Infant wide-field retinal image: 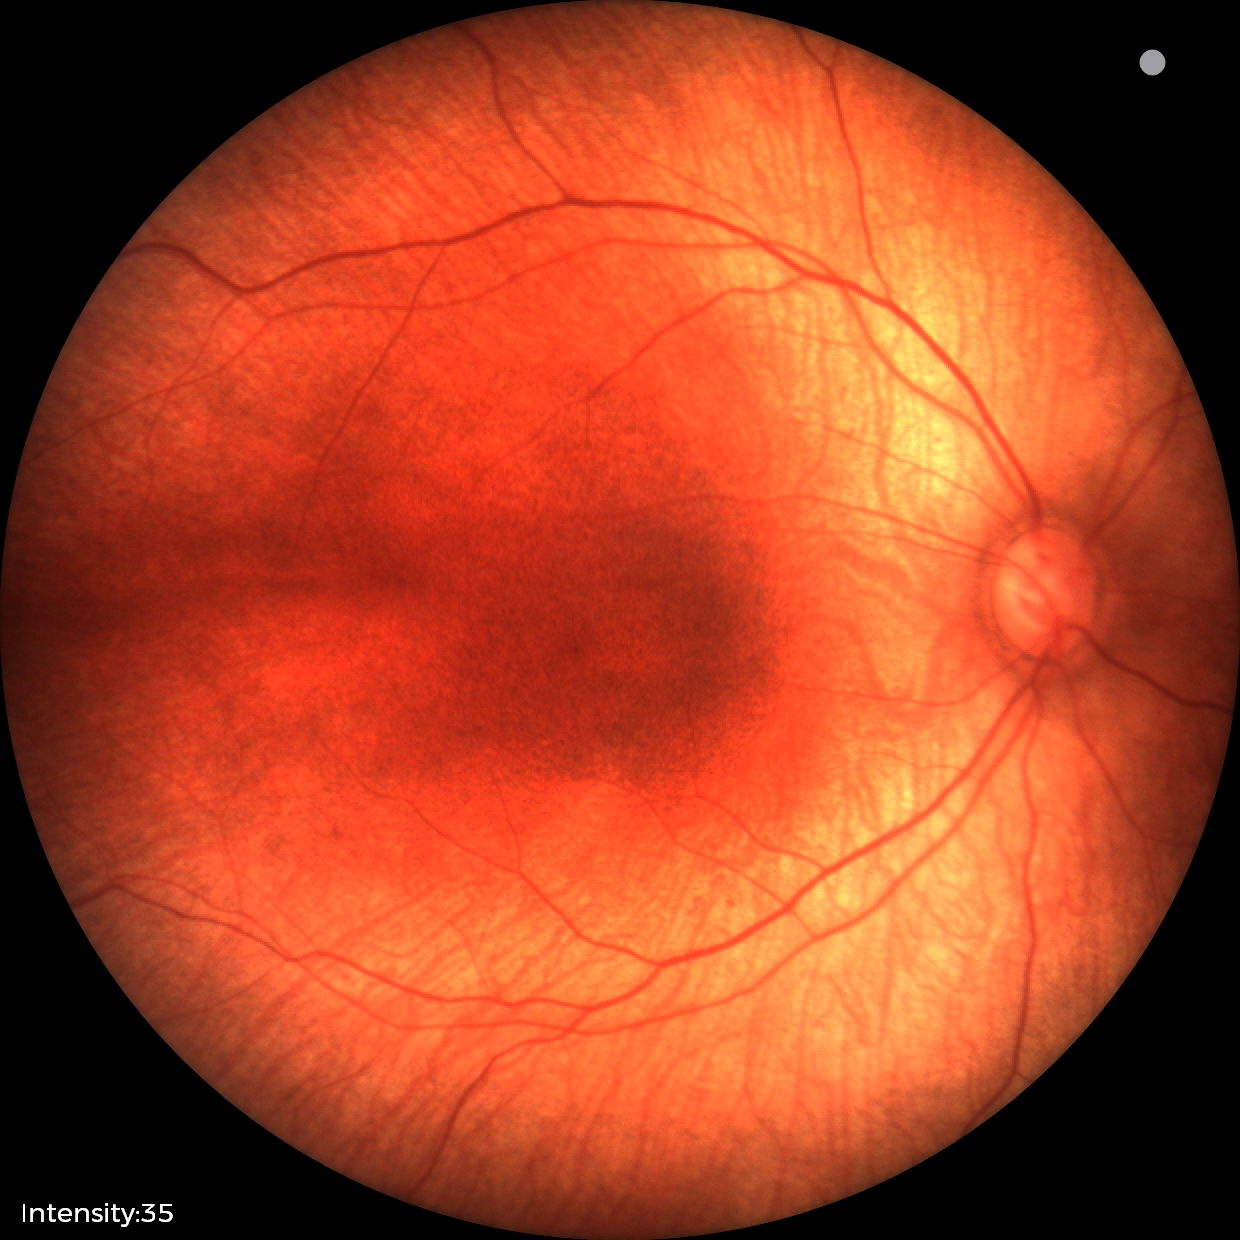
Examination with physiological retinal findings.